FOV: 45 degrees
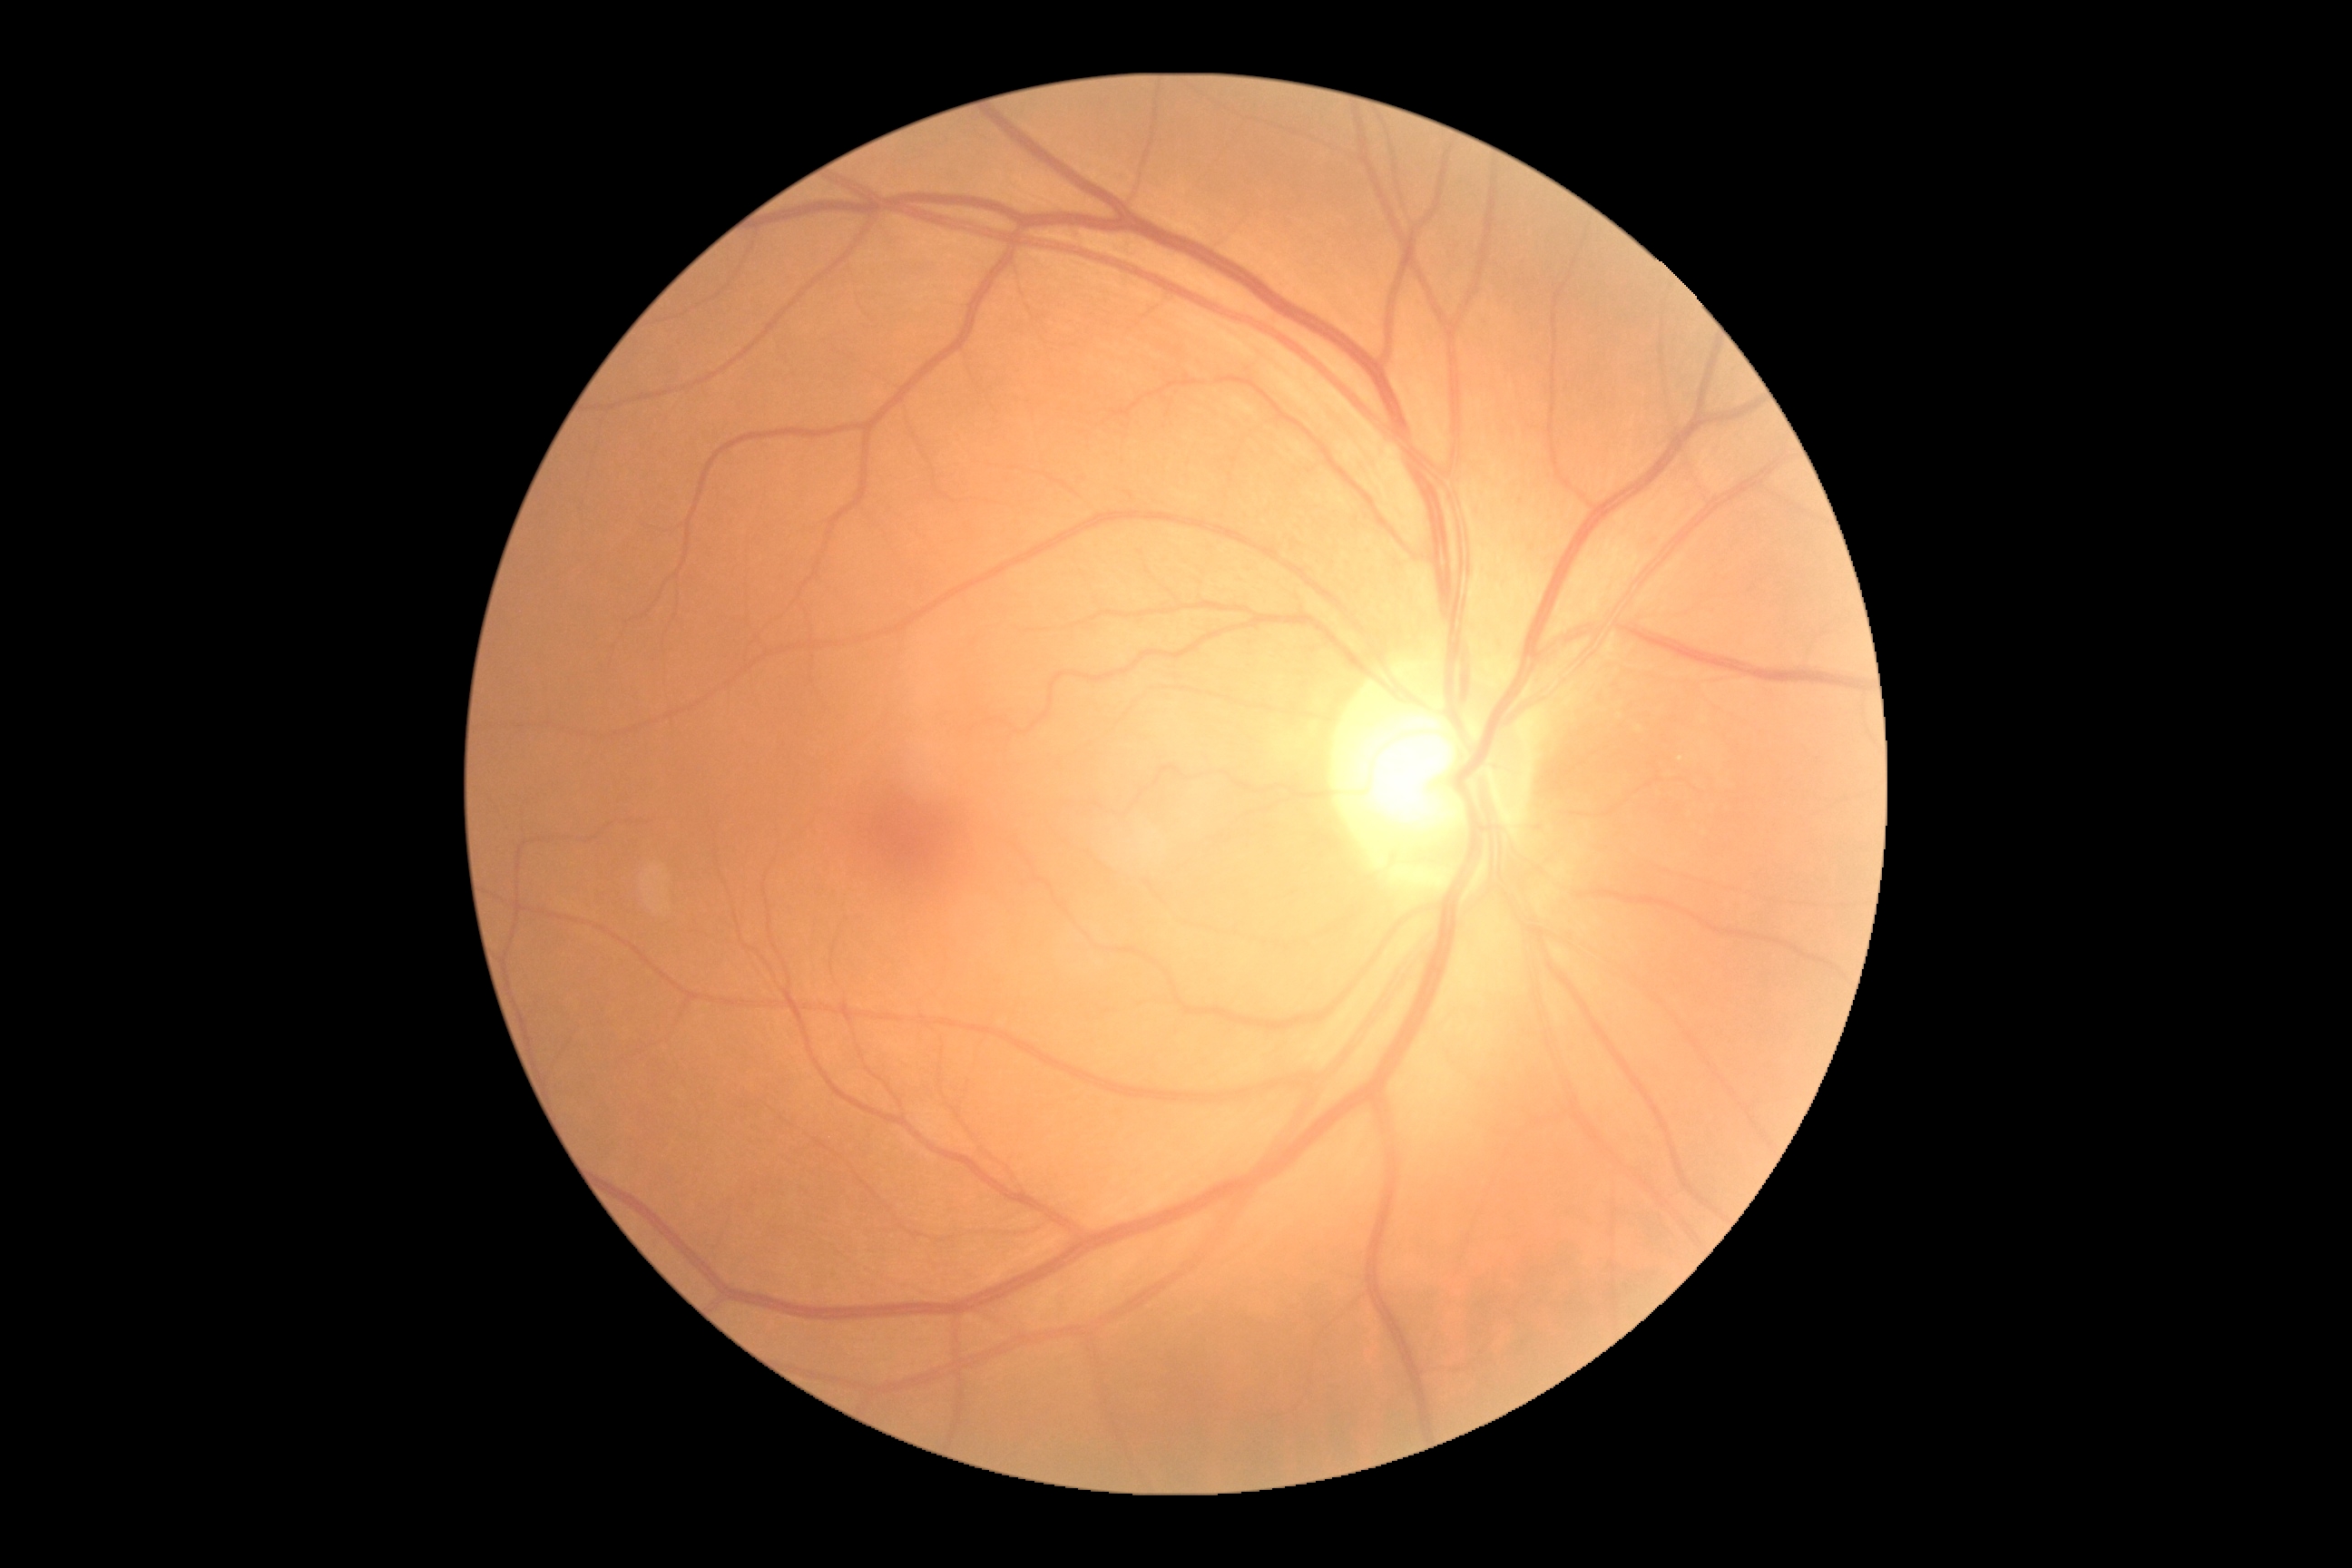

retinopathy=0/4.